Color fundus photograph:
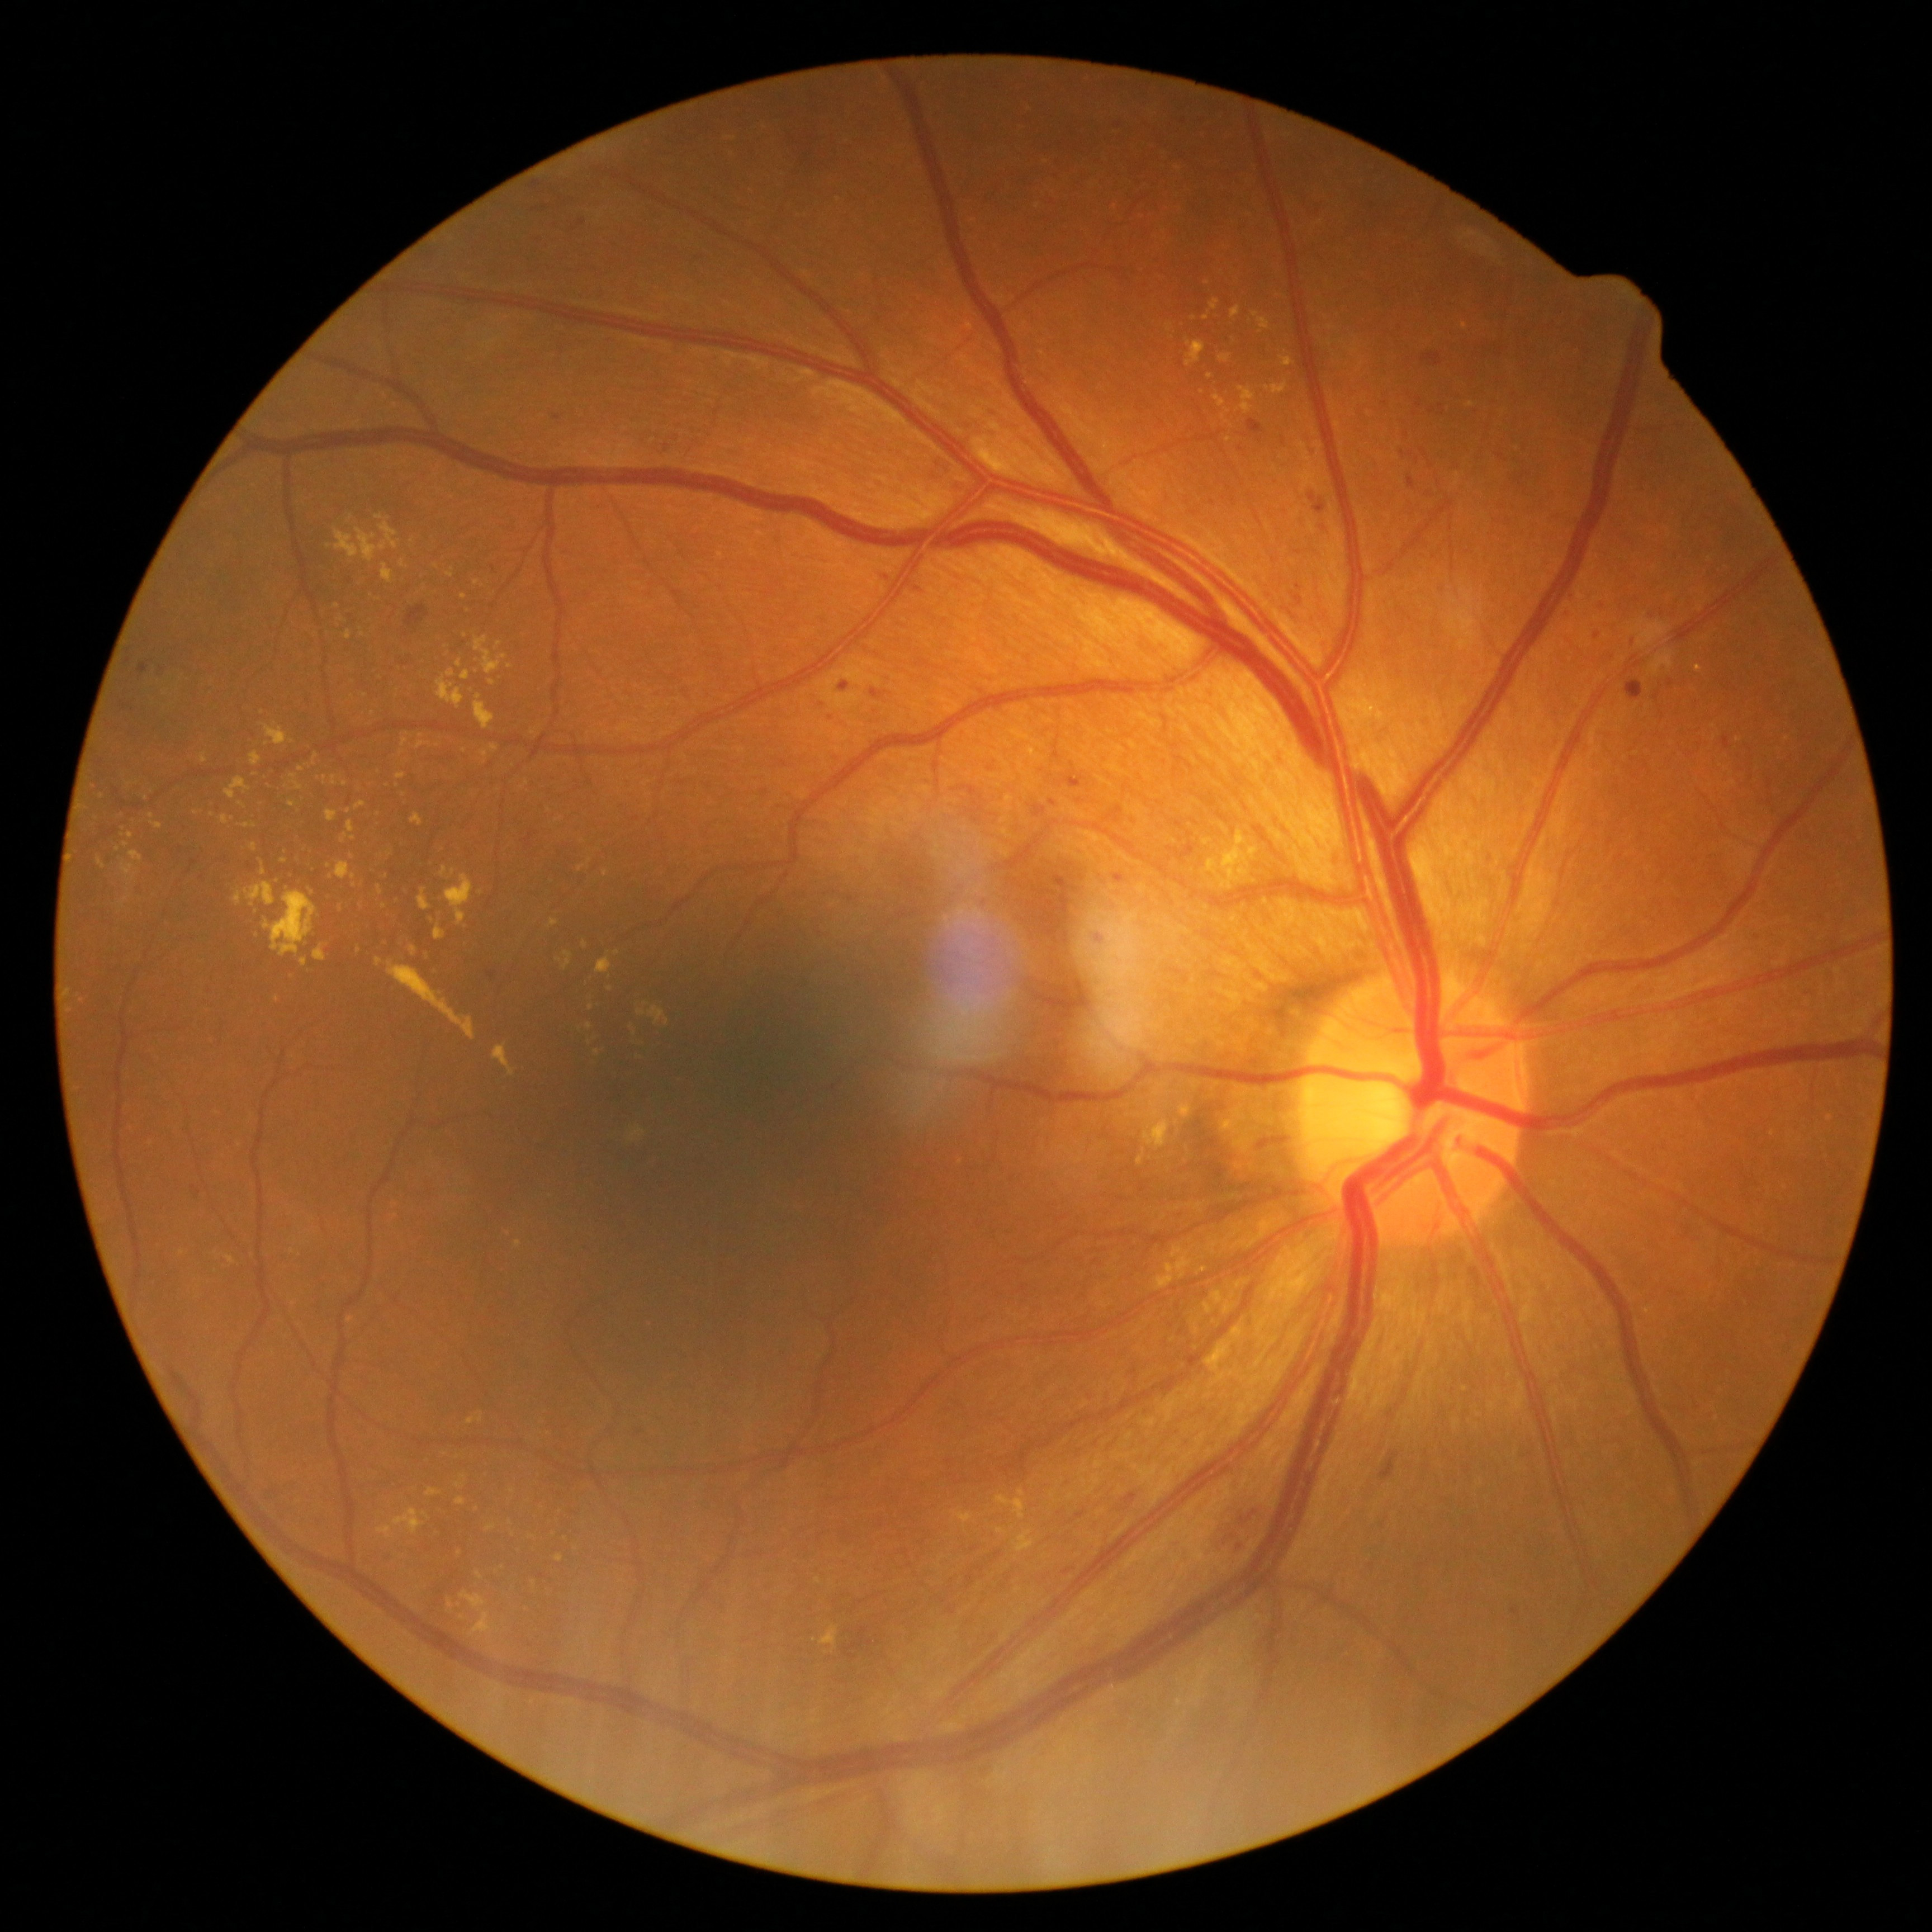 Diabetic retinopathy is 2/4. Hard exudates include those at box=[128, 831, 134, 839], box=[250, 842, 258, 851], box=[153, 822, 164, 830], box=[1144, 1103, 1200, 1161], box=[401, 738, 409, 745], box=[420, 887, 432, 911], box=[1186, 342, 1205, 368], box=[433, 925, 447, 940], box=[1214, 395, 1225, 408], box=[1281, 357, 1293, 366], box=[477, 1570, 484, 1579], box=[438, 670, 465, 708]. Small hard exudates approximately at x=637, y=722, x=510, y=666, x=460, y=1552, x=503, y=1567, x=402, y=564, x=590, y=1042, x=450, y=576, x=242, y=805.